NIDEK AFC-230 fundus camera; 848 x 848 pixels; retinal fundus photograph; 45 degree fundus photograph: 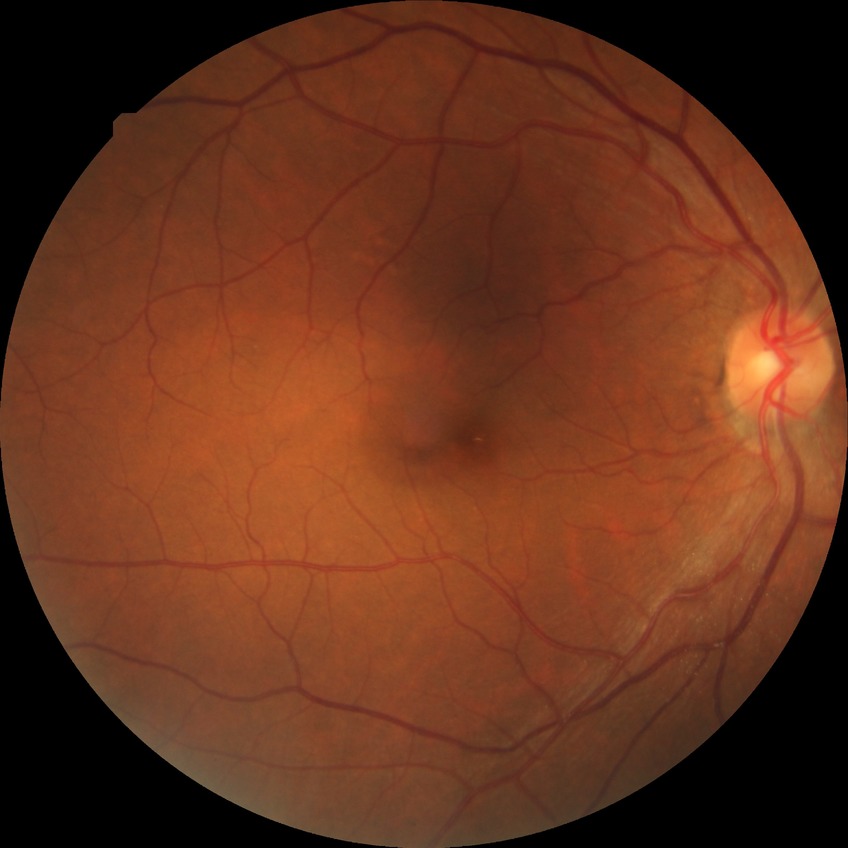 - DR — NDR